Infant wide-field retinal image: 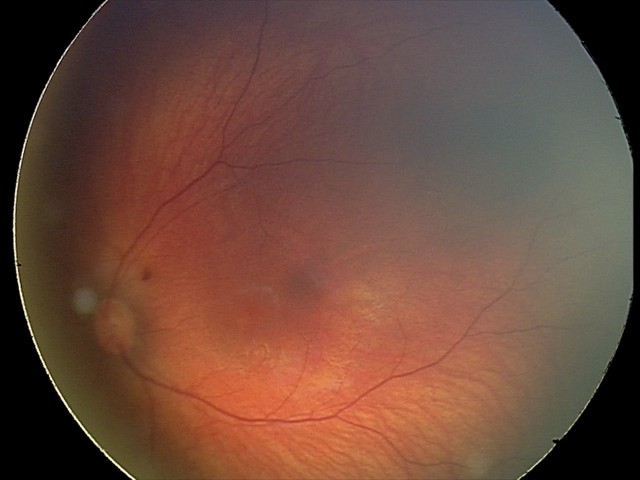

Screening examination consistent with retinal hemorrhages.